Infant wide-field fundus photograph. 130° field of view (Natus RetCam Envision): 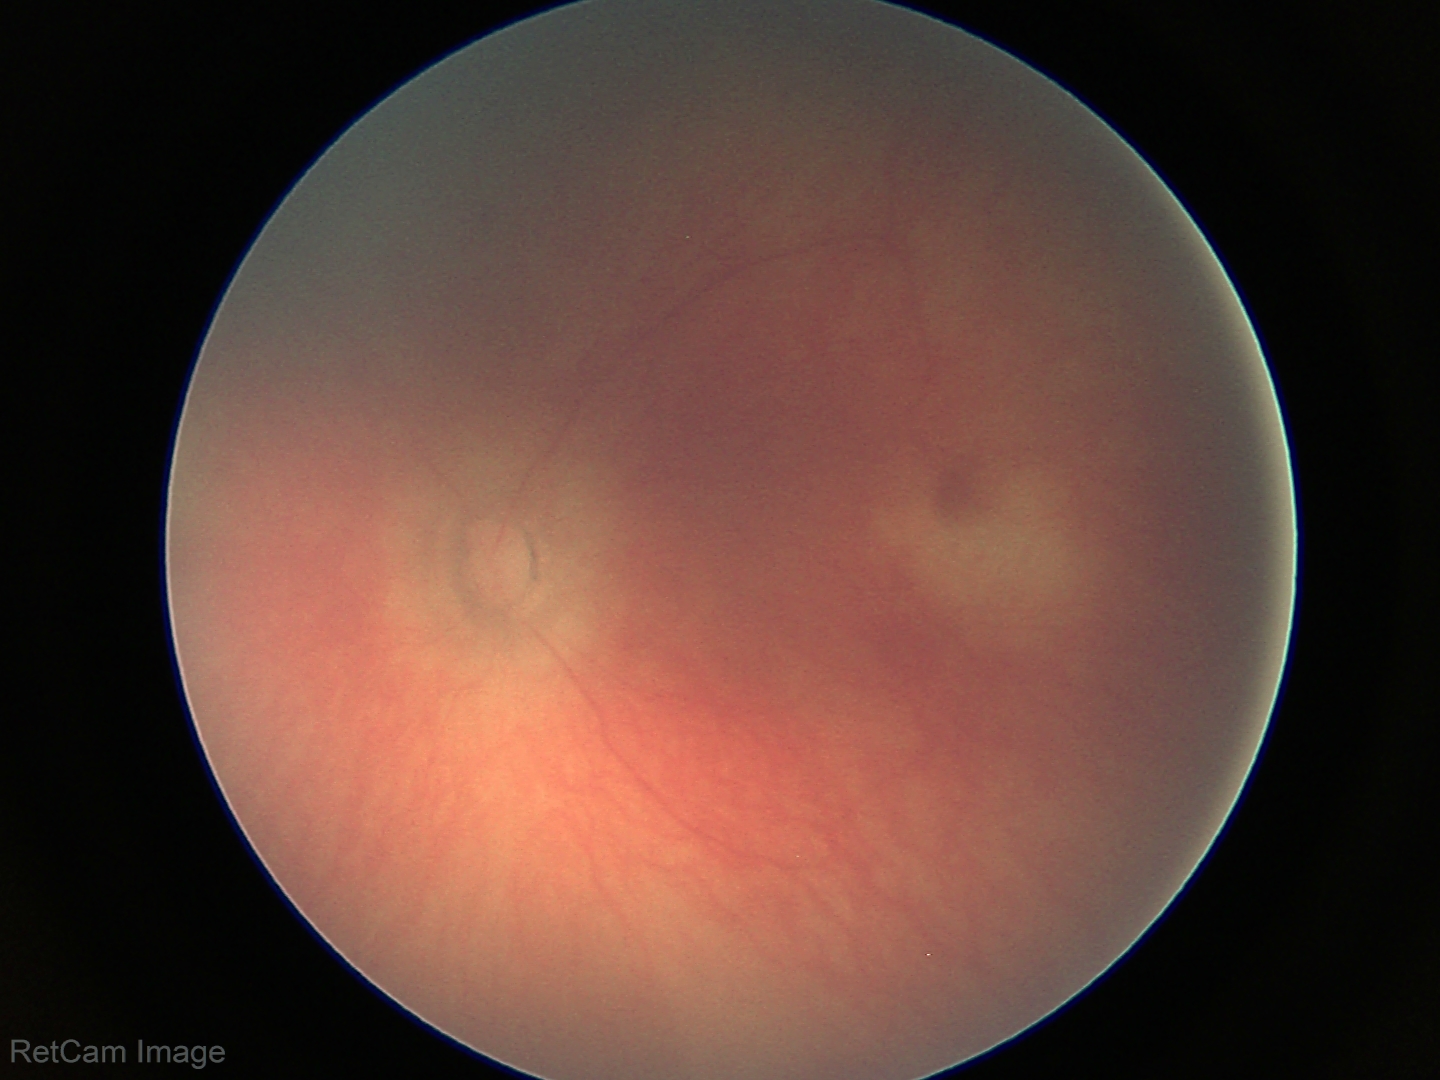

Assessment = normal retinal appearance